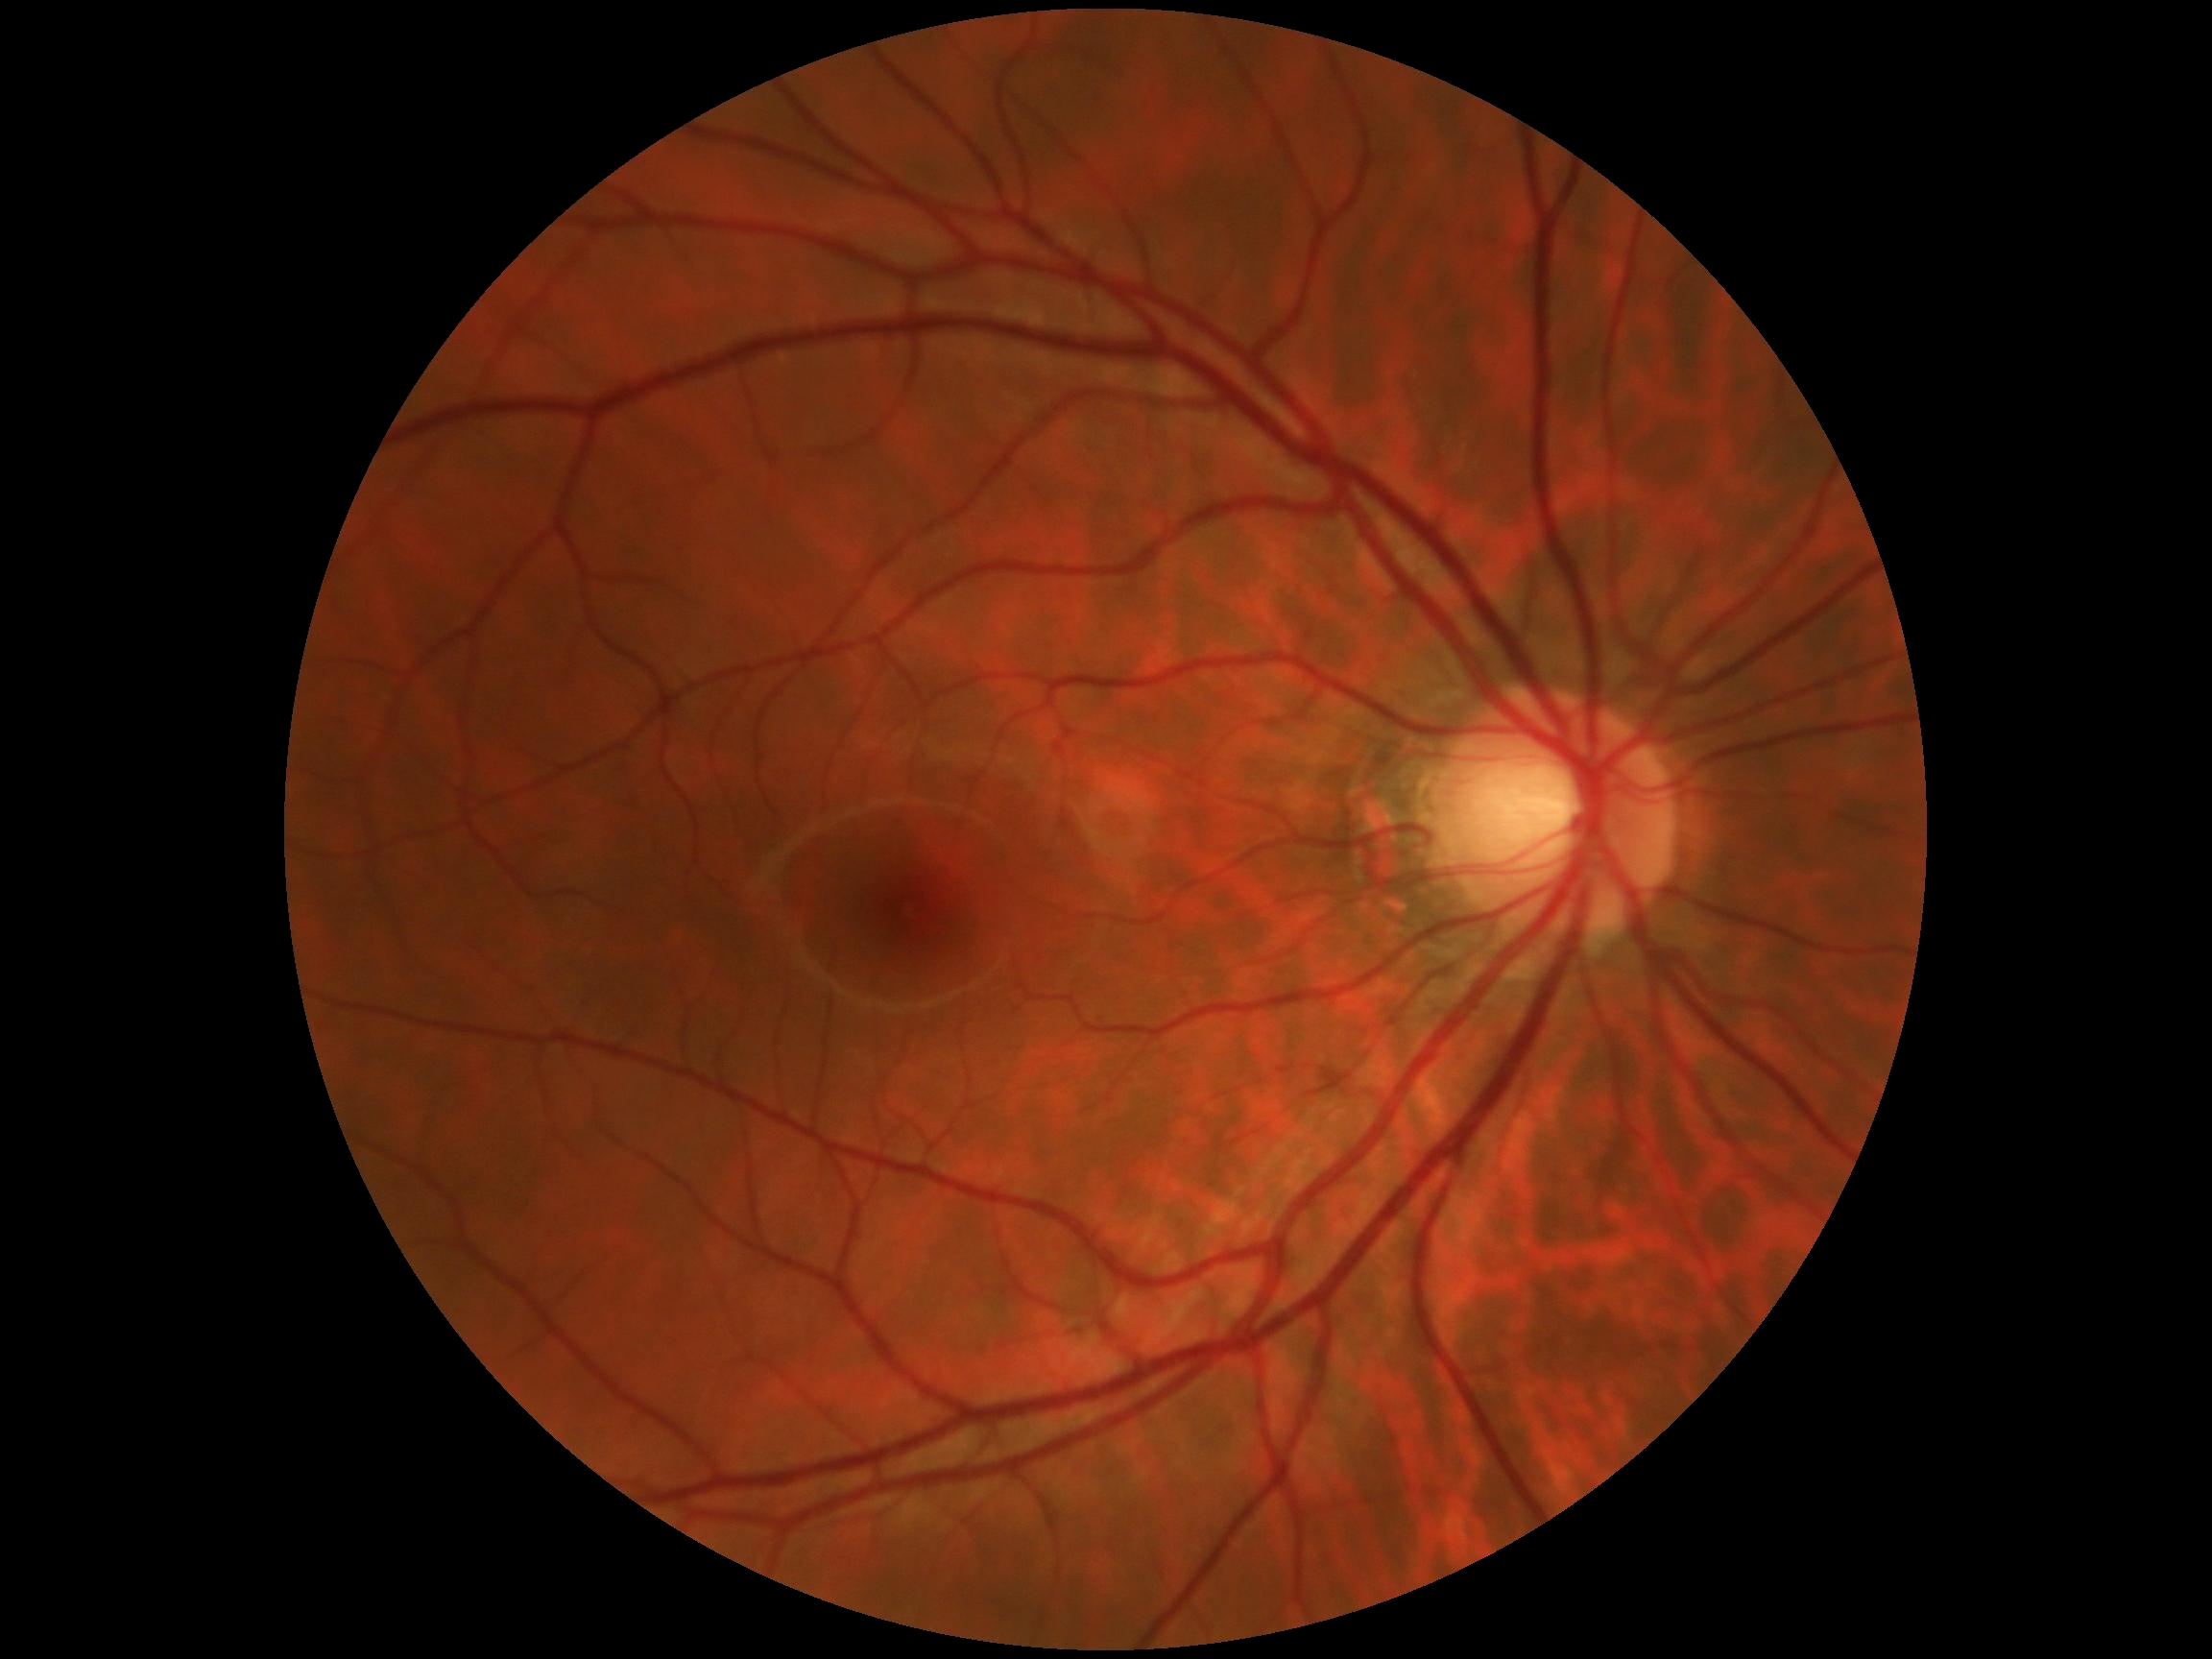

No signs of diabetic retinopathy. Diabetic retinopathy (DR): grade 0 — no visible signs of diabetic retinopathy.